No pharmacologic dilation; color fundus photograph; diabetic retinopathy graded by the modified Davis classification; image size 848x848; camera: NIDEK AFC-230; 45 degree fundus photograph — 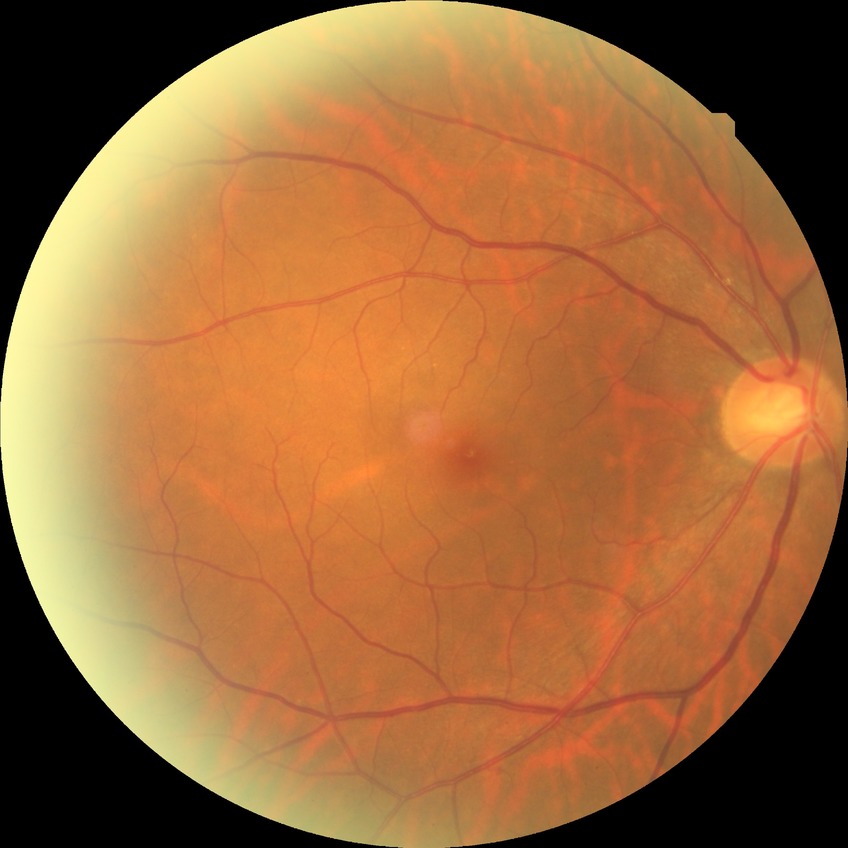 Assessment:
• diabetic retinopathy (DR) — no diabetic retinopathy (NDR)